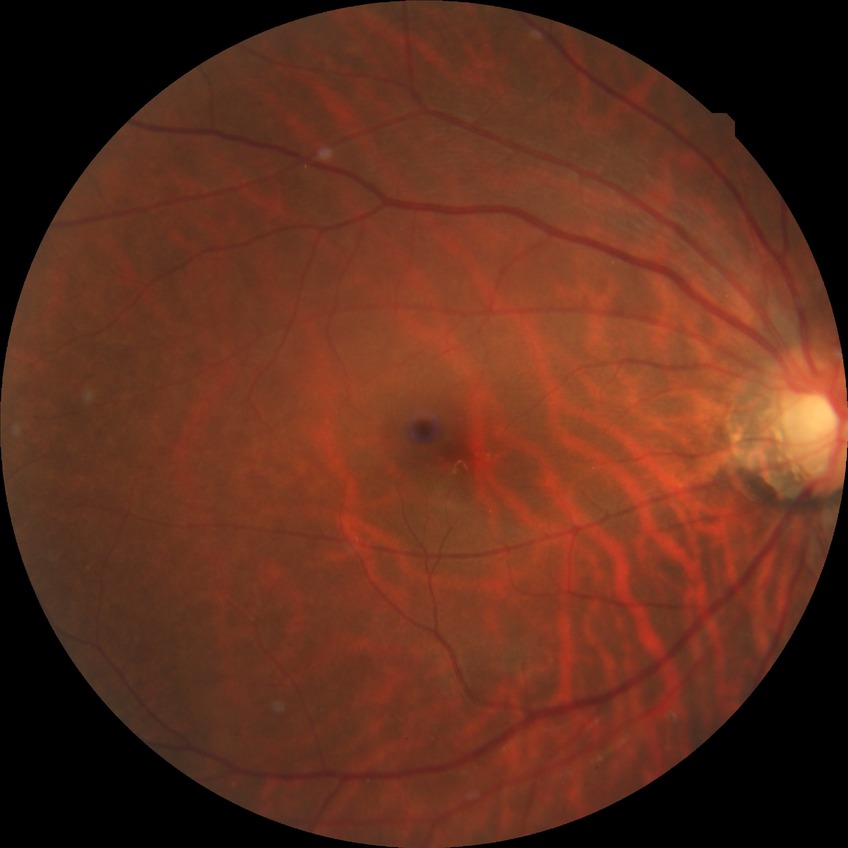

DR=NDR, DR impression=no signs of DR.